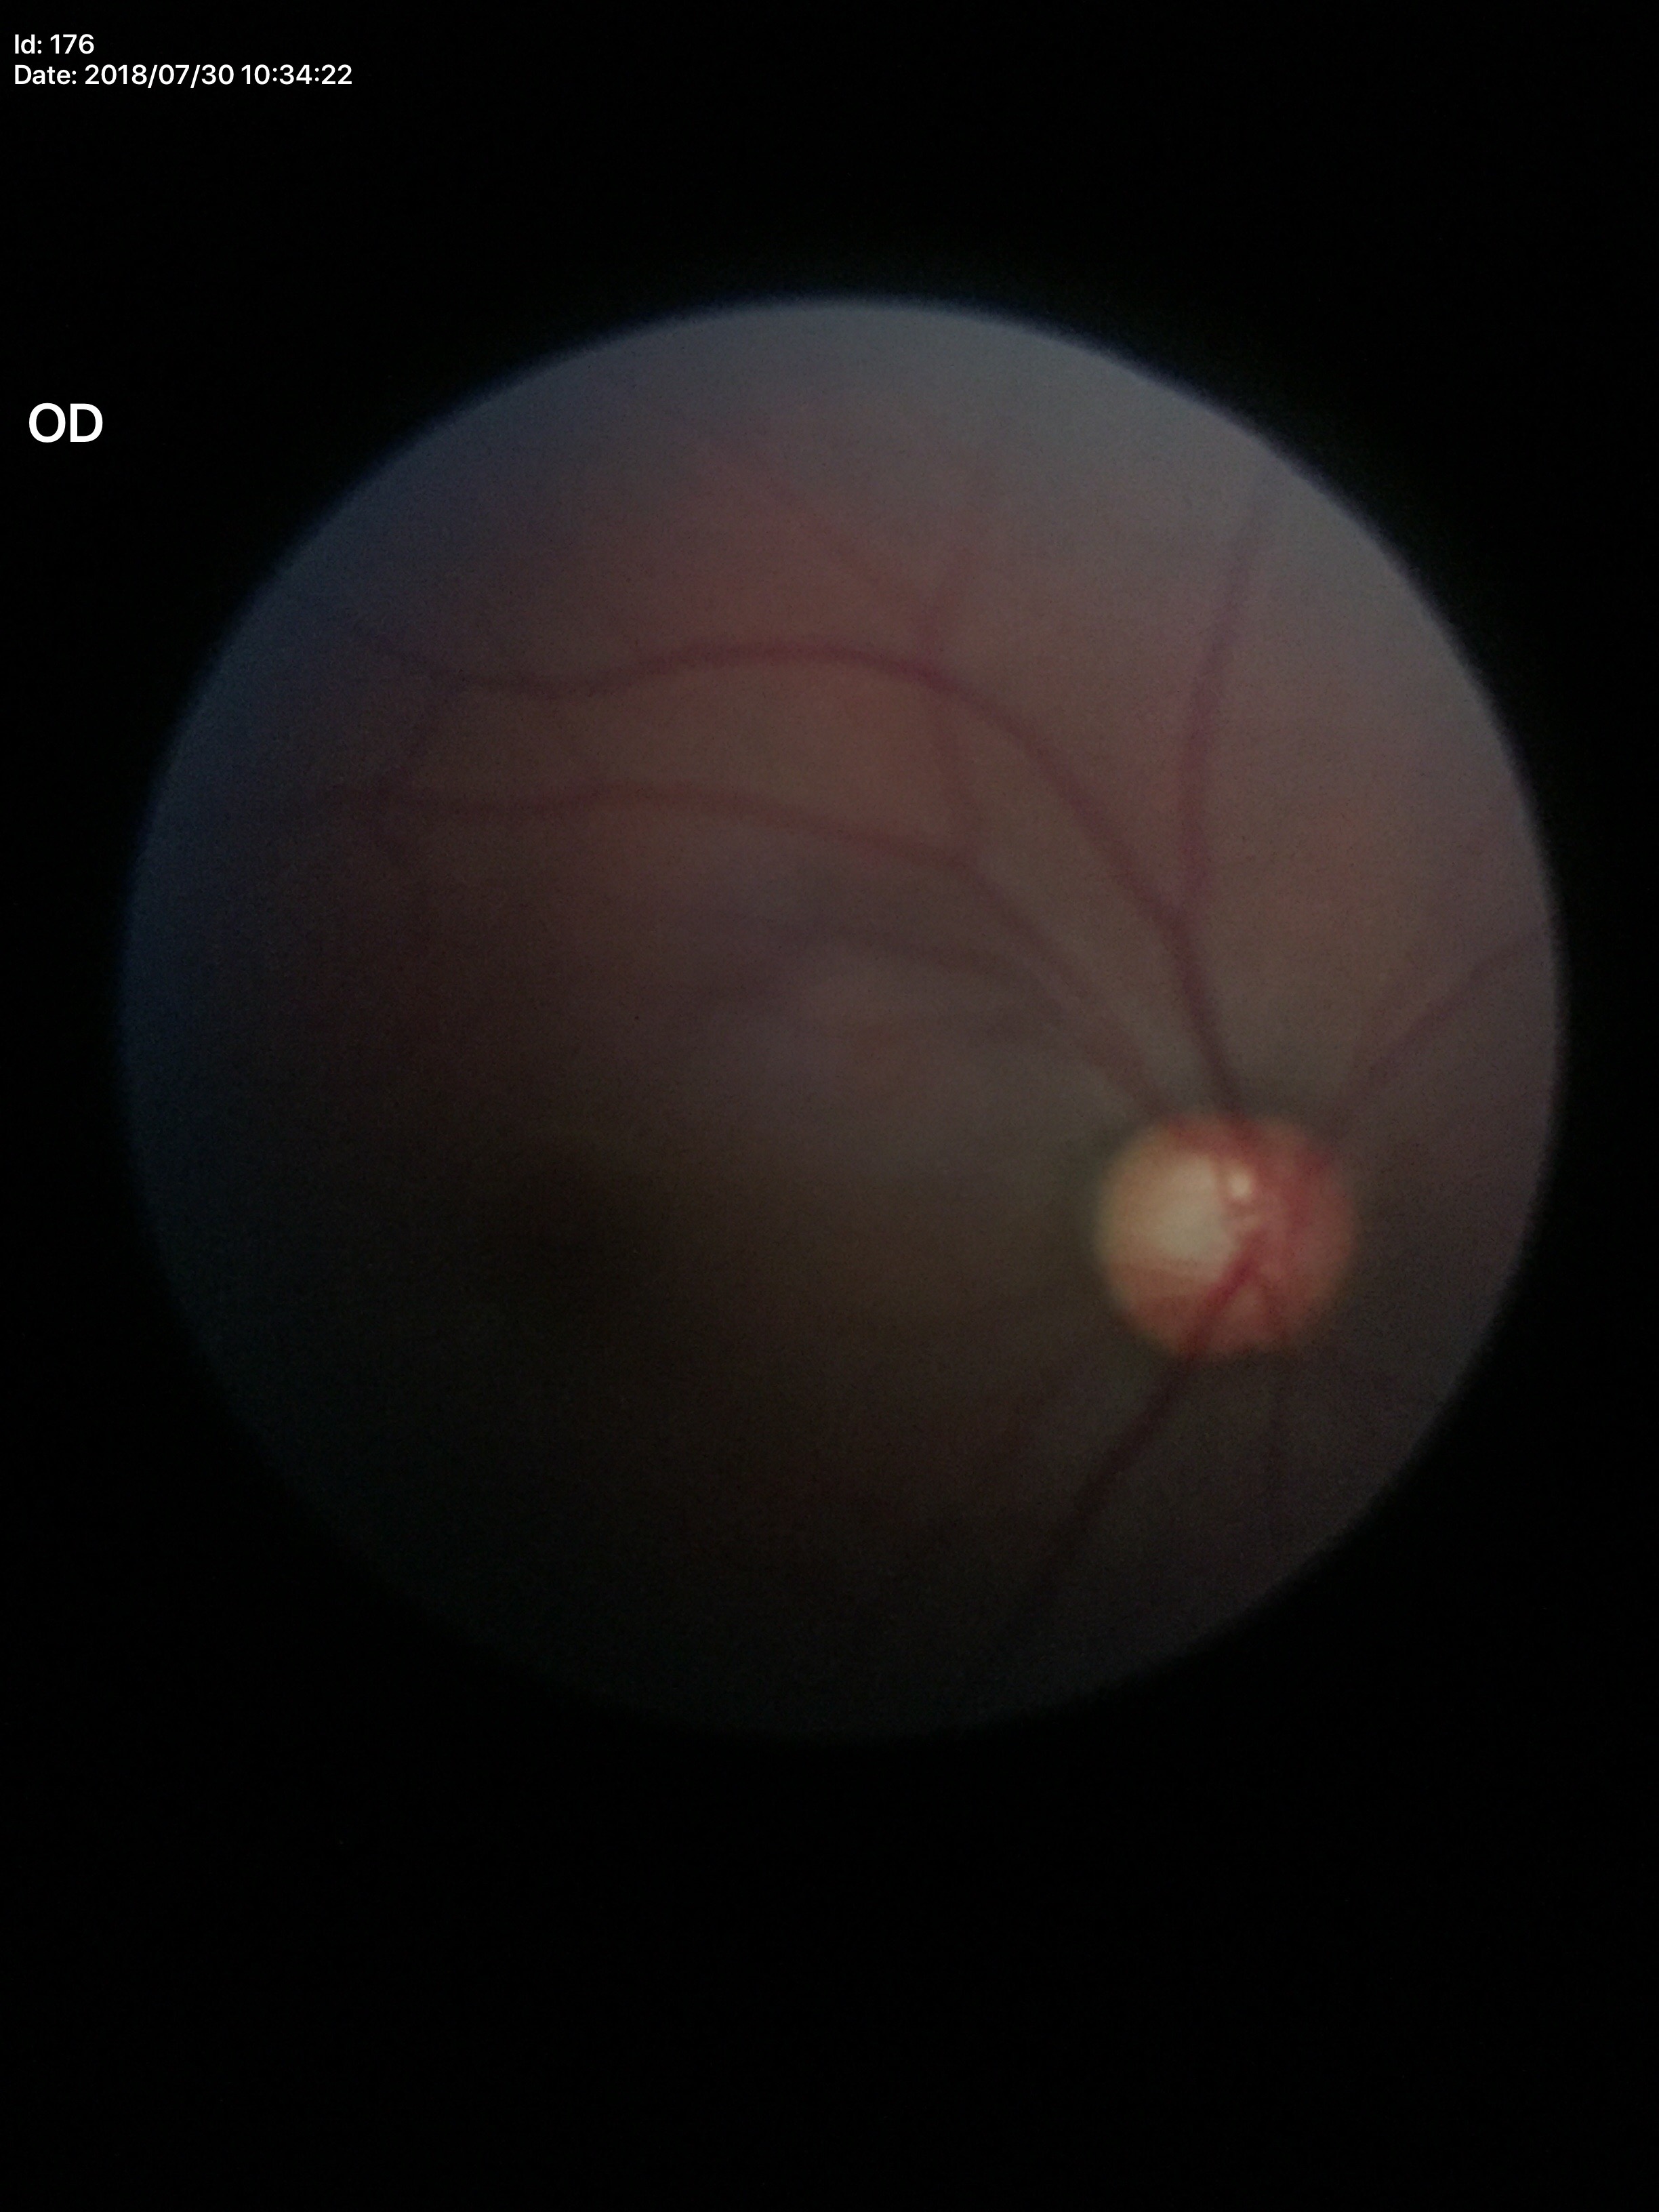
Glaucoma evaluation: not suspect.
Vertical cup-to-disc ratio (VCDR) is 0.56.
Area C/D ratio (ACDR) of 0.33.